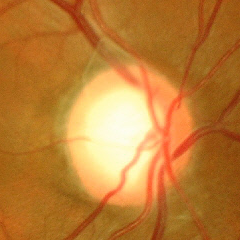
This fundus photograph shows advanced glaucoma.